FOV: 45 degrees:
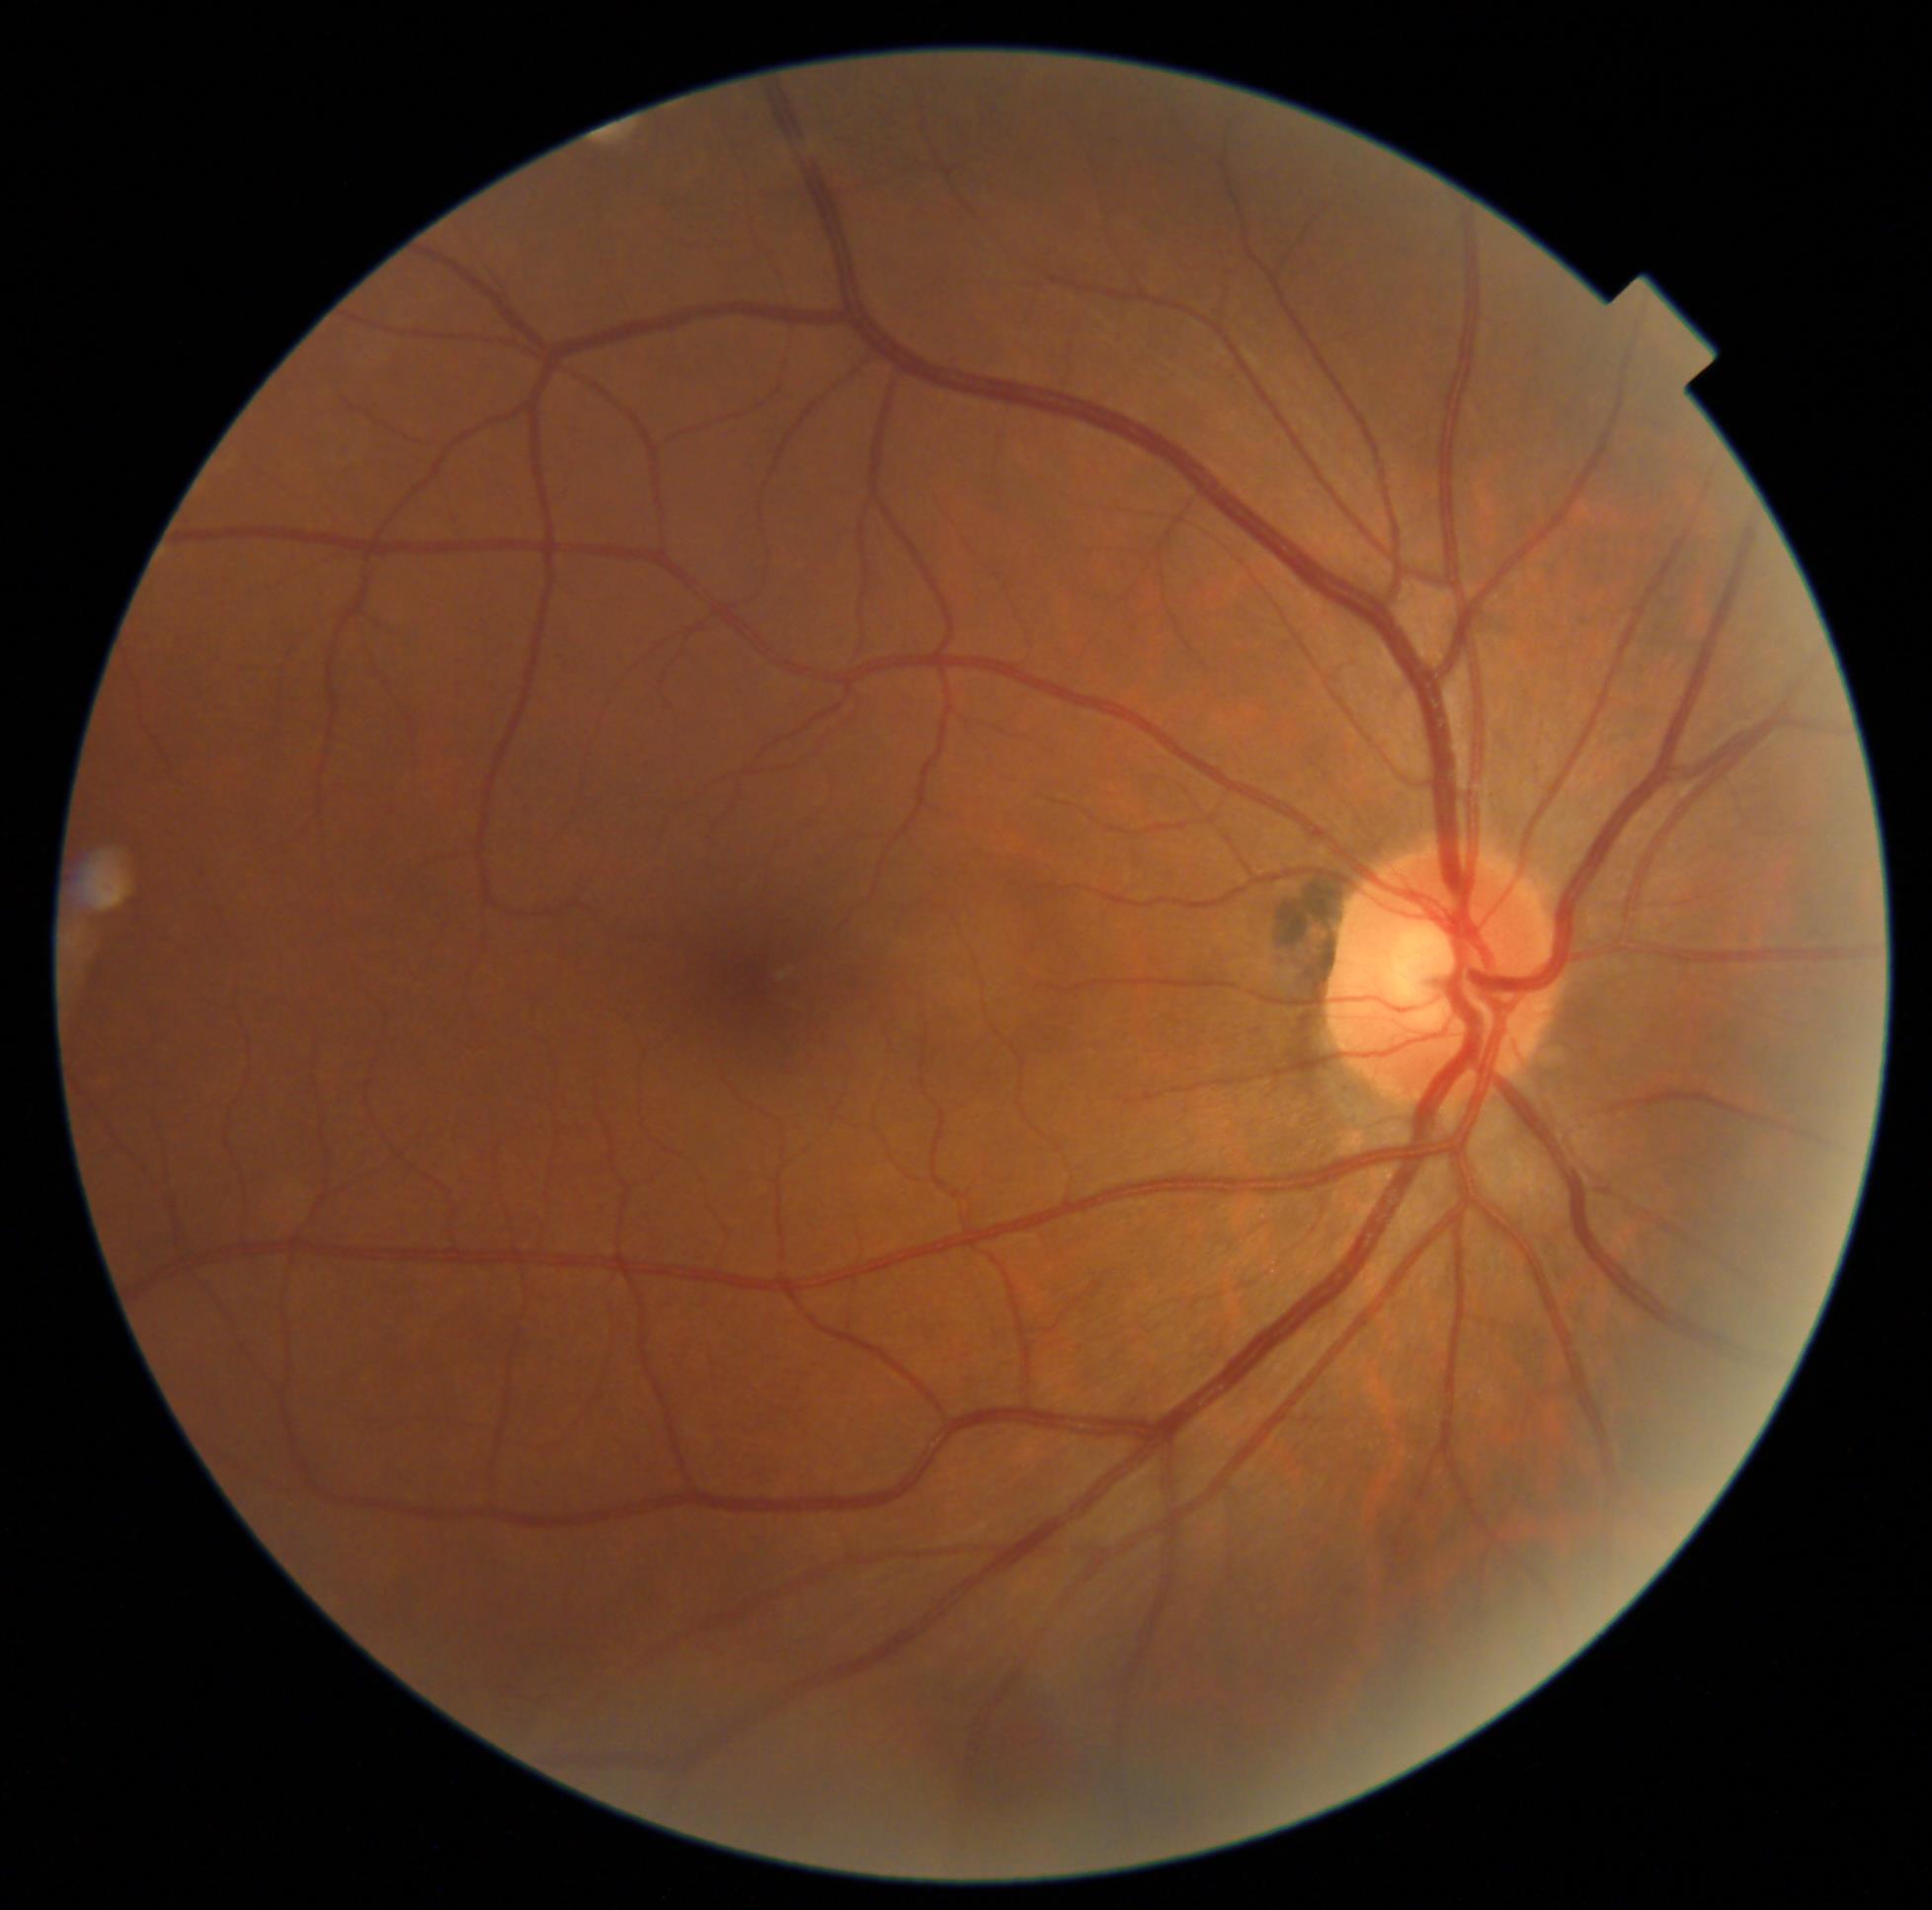 DR impression: no signs of DR, retinopathy grade: 0 (no apparent retinopathy).